45-degree field of view, retinal fundus photograph, 2352 by 1568 pixels
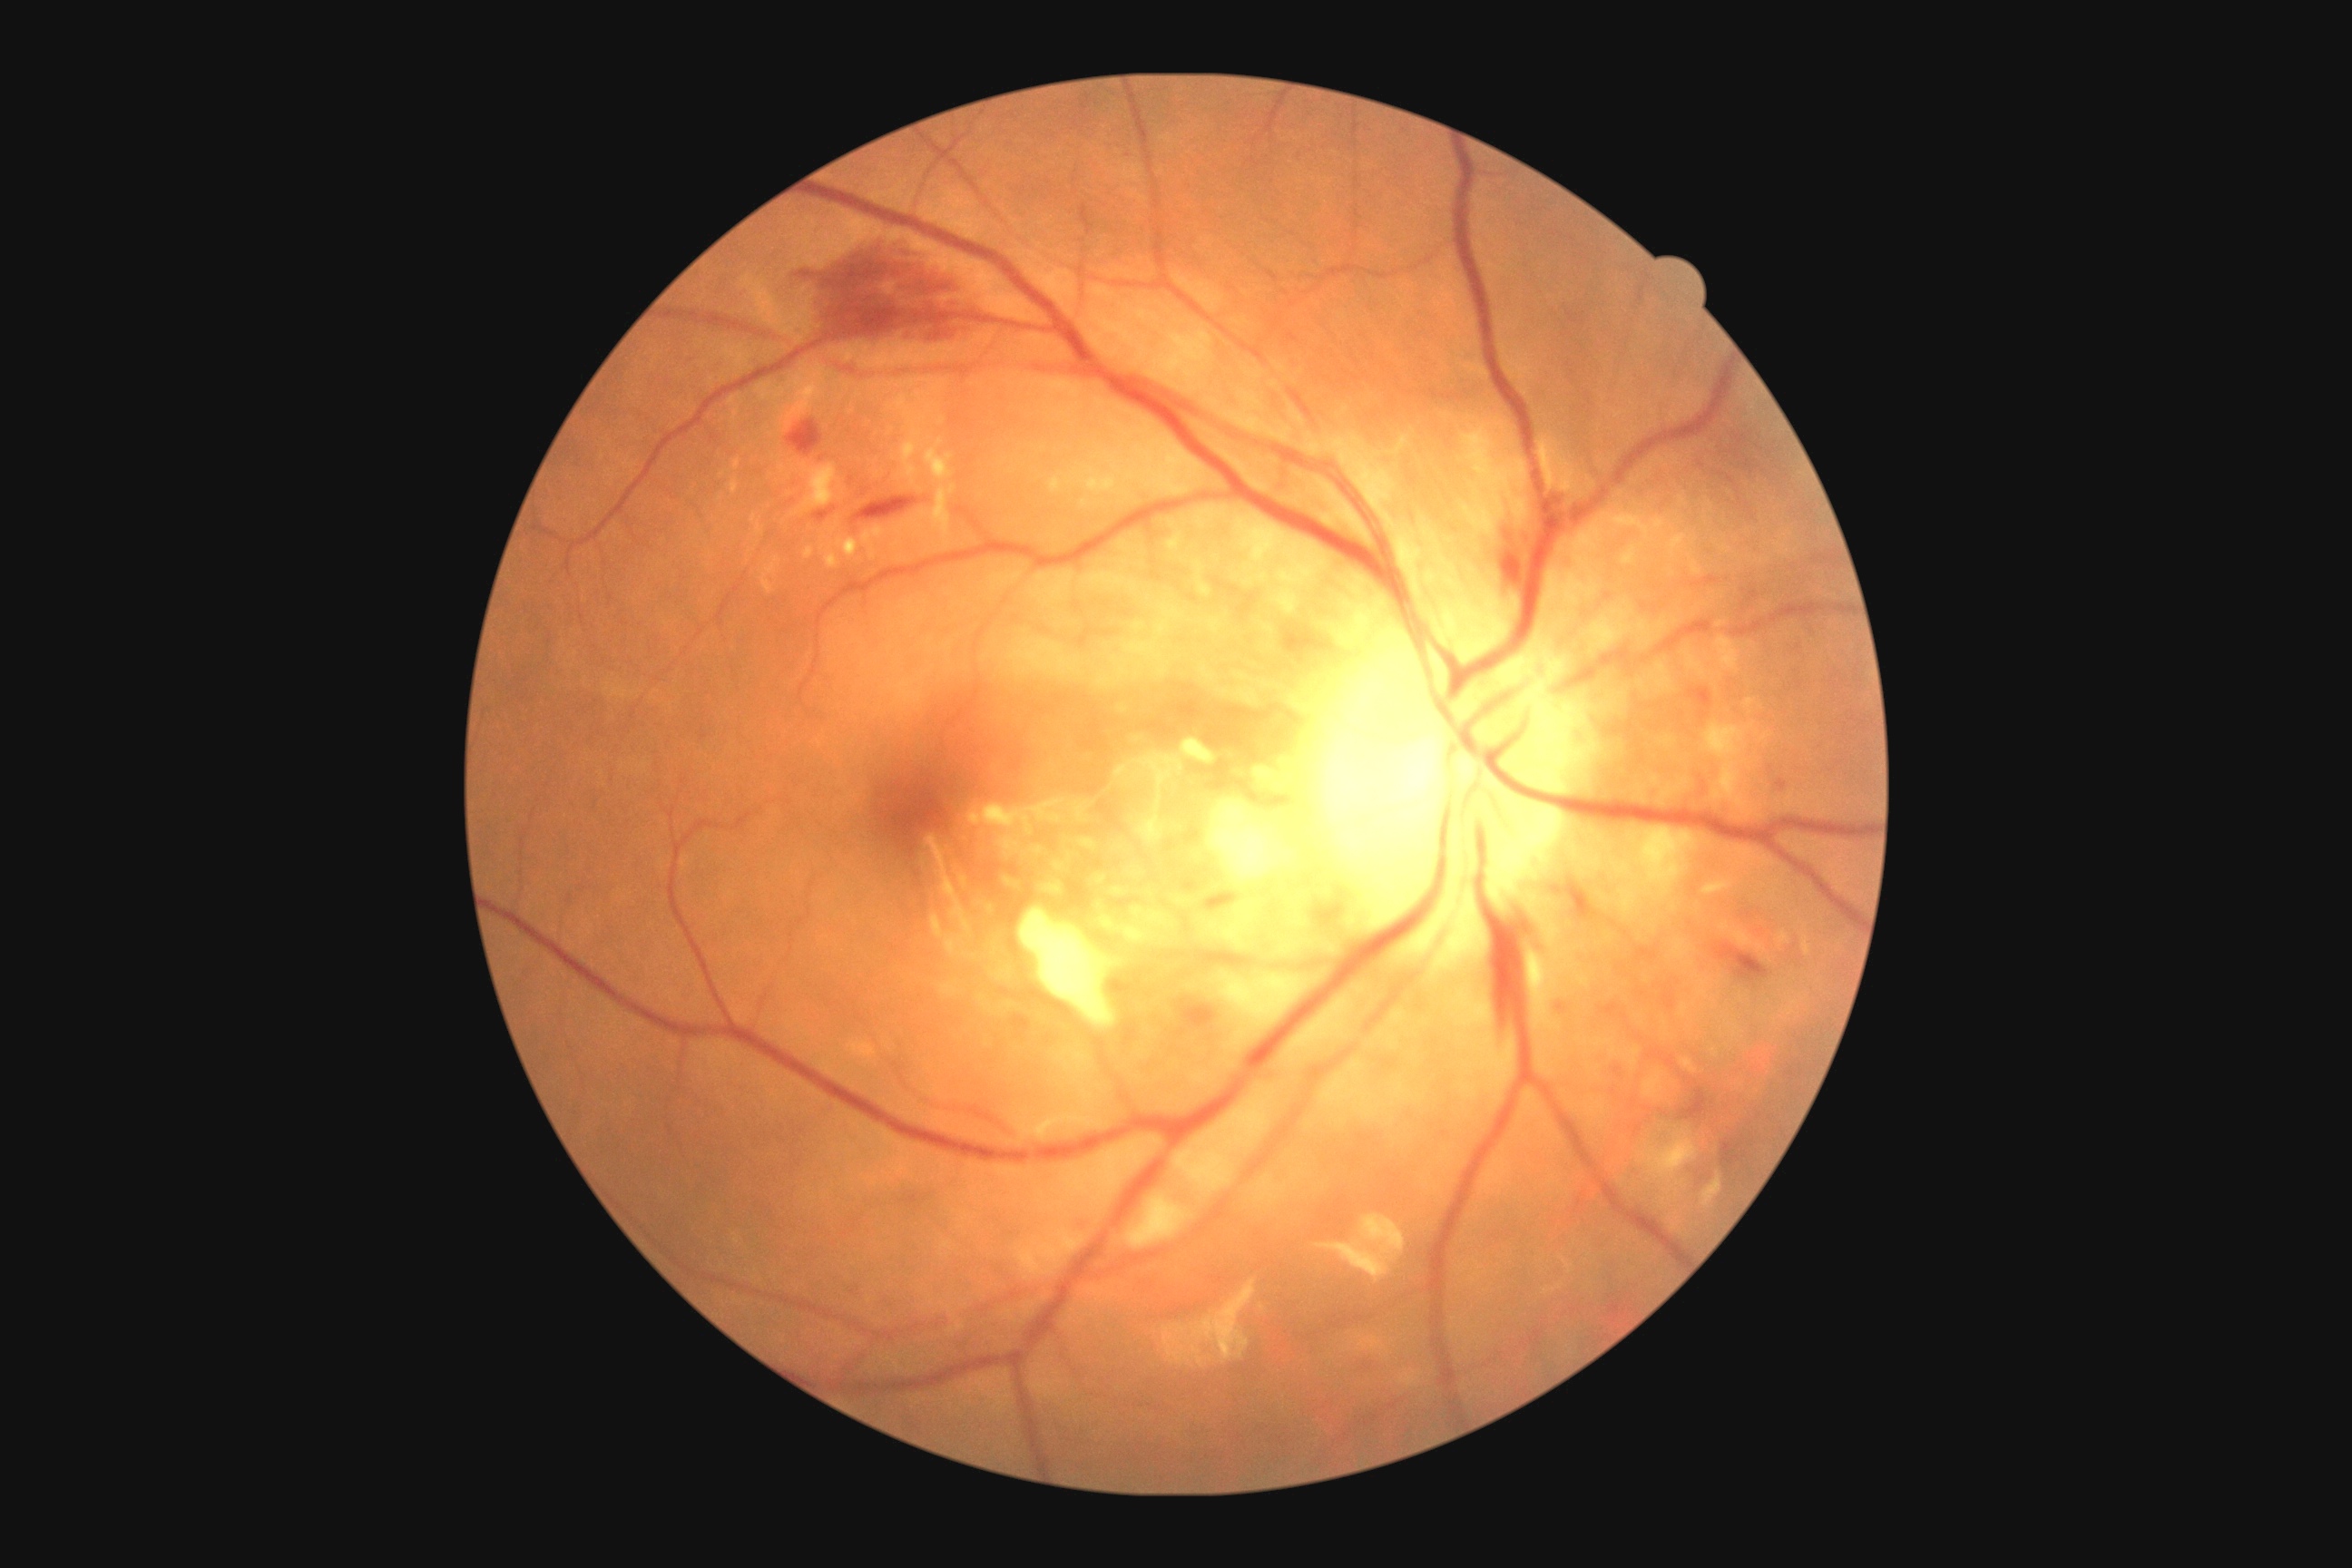 DR stage: 2.